Color fundus photograph; 50-degree field of view; macula at the center of the field: 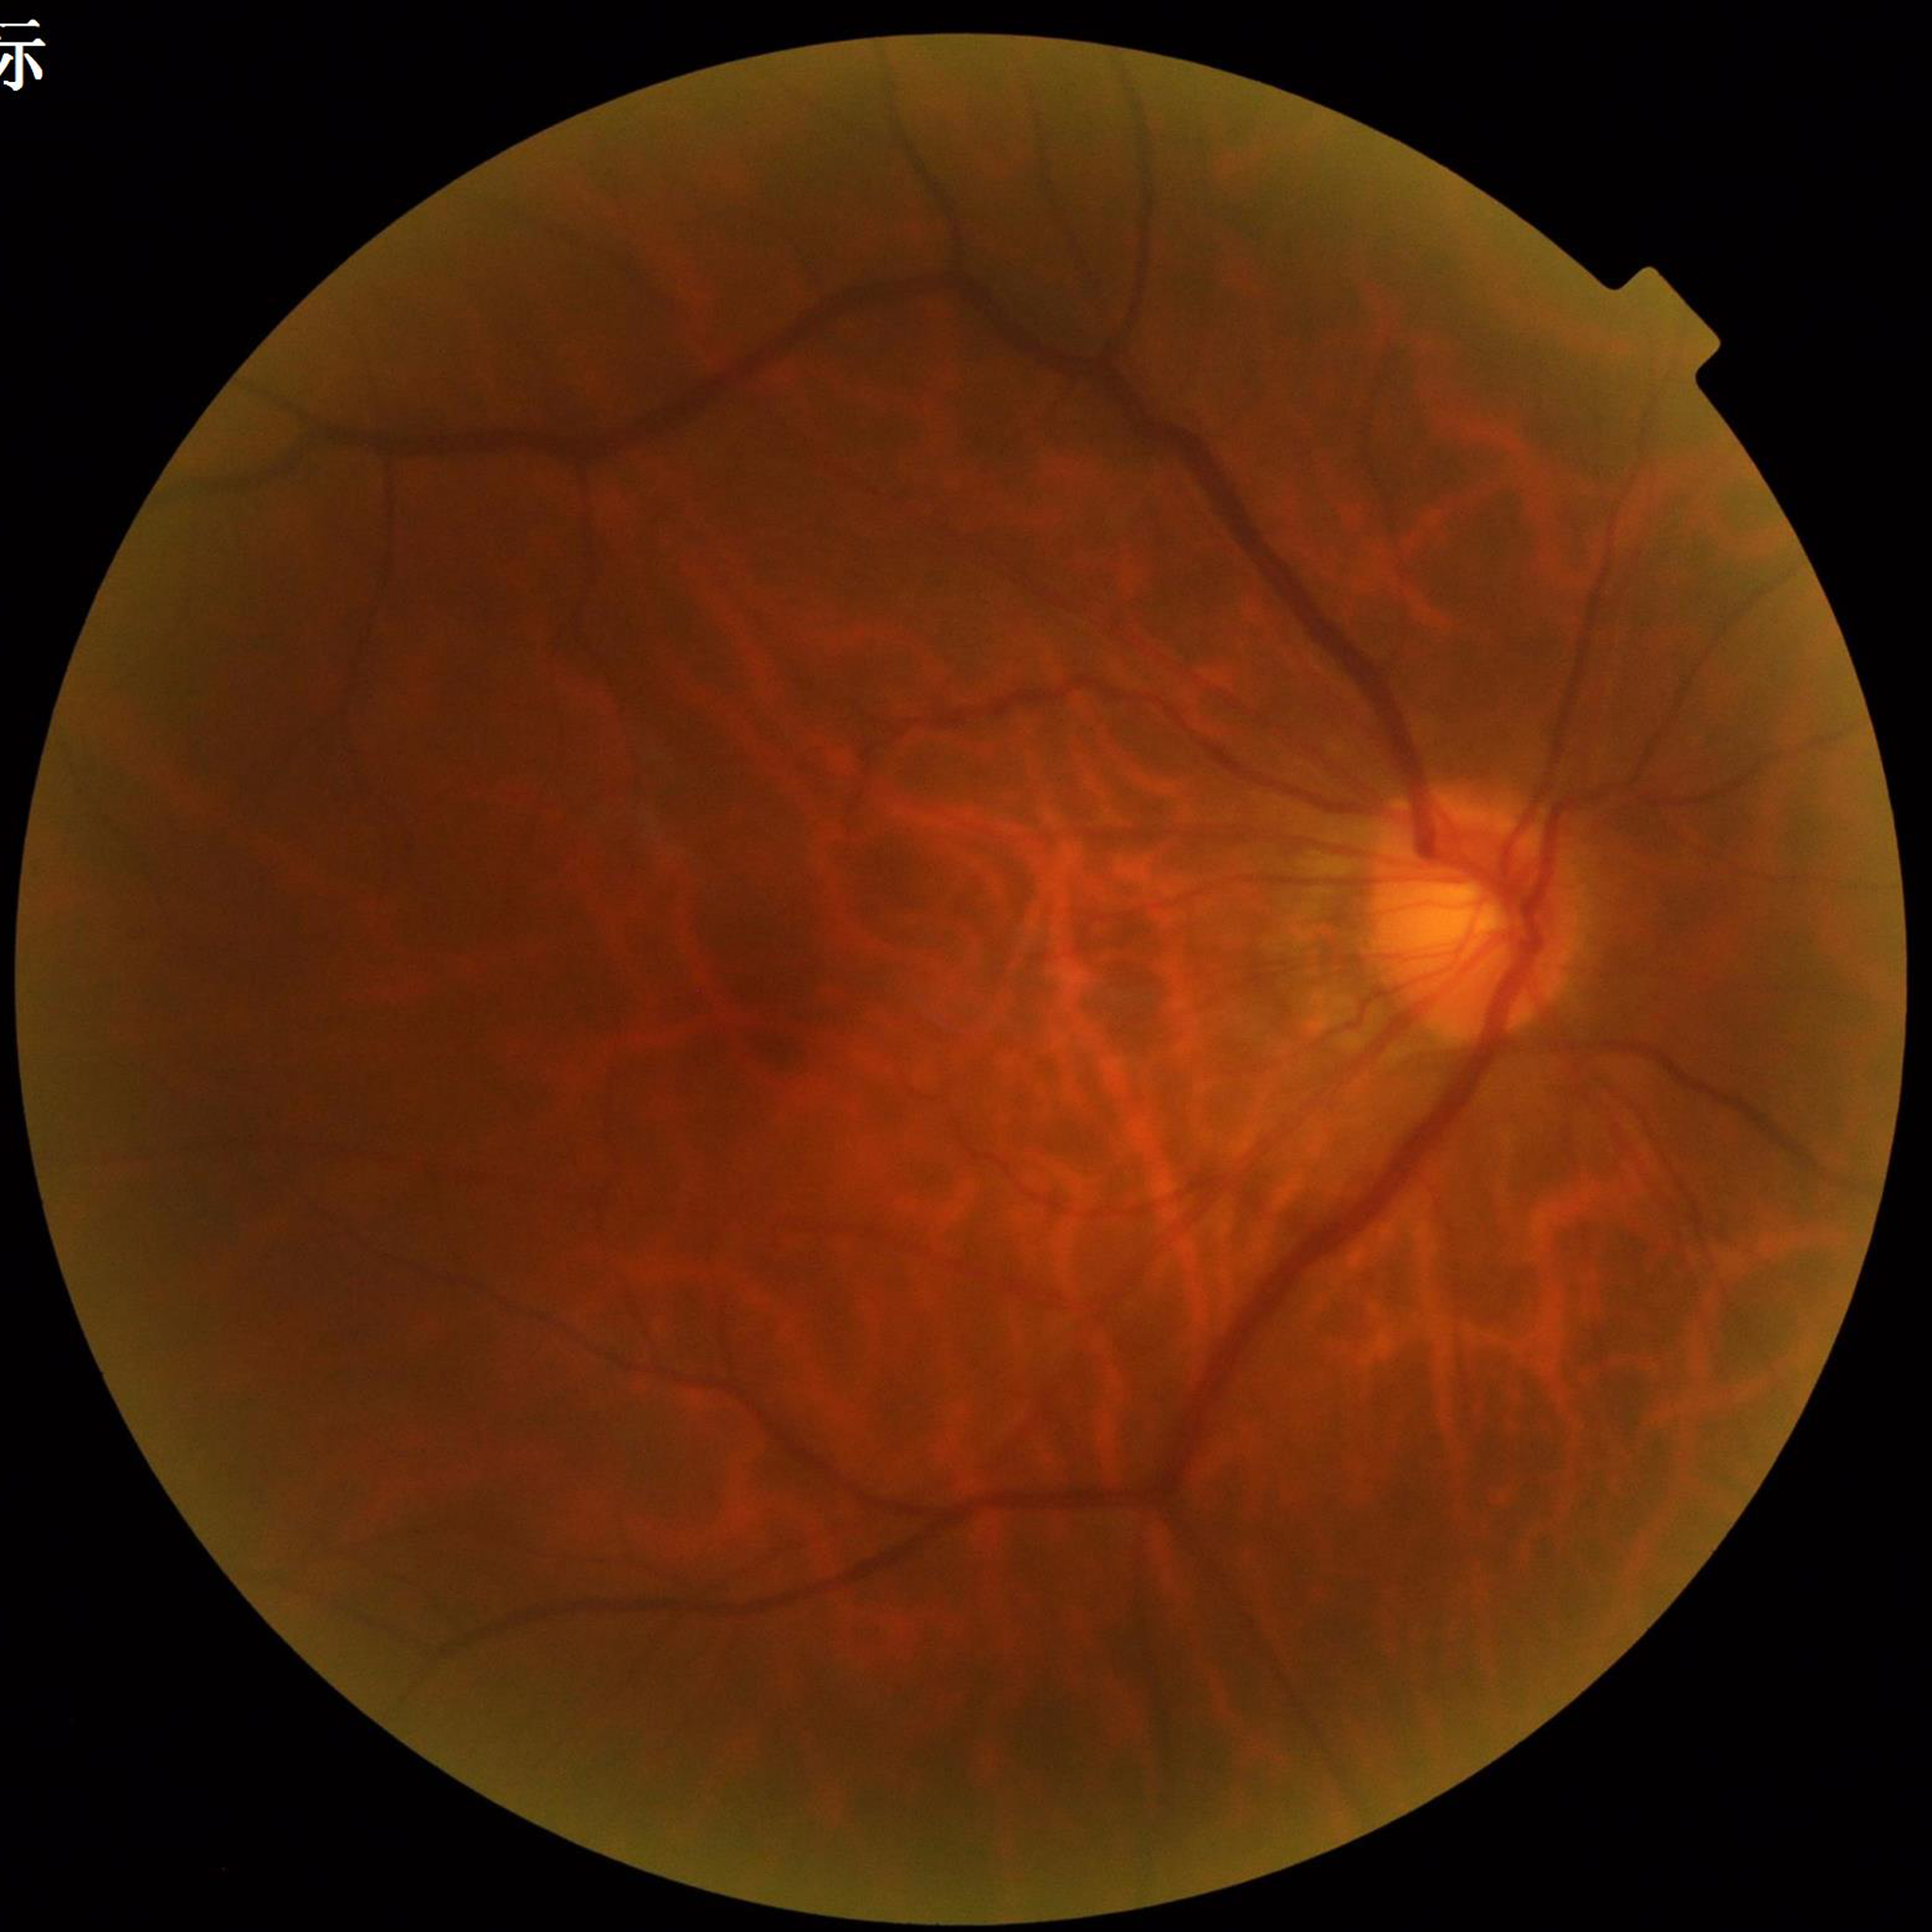 The patient was diagnosed with diabetic retinopathy.
Quality: suboptimal — illumination/color distortion.